45-degree field of view: 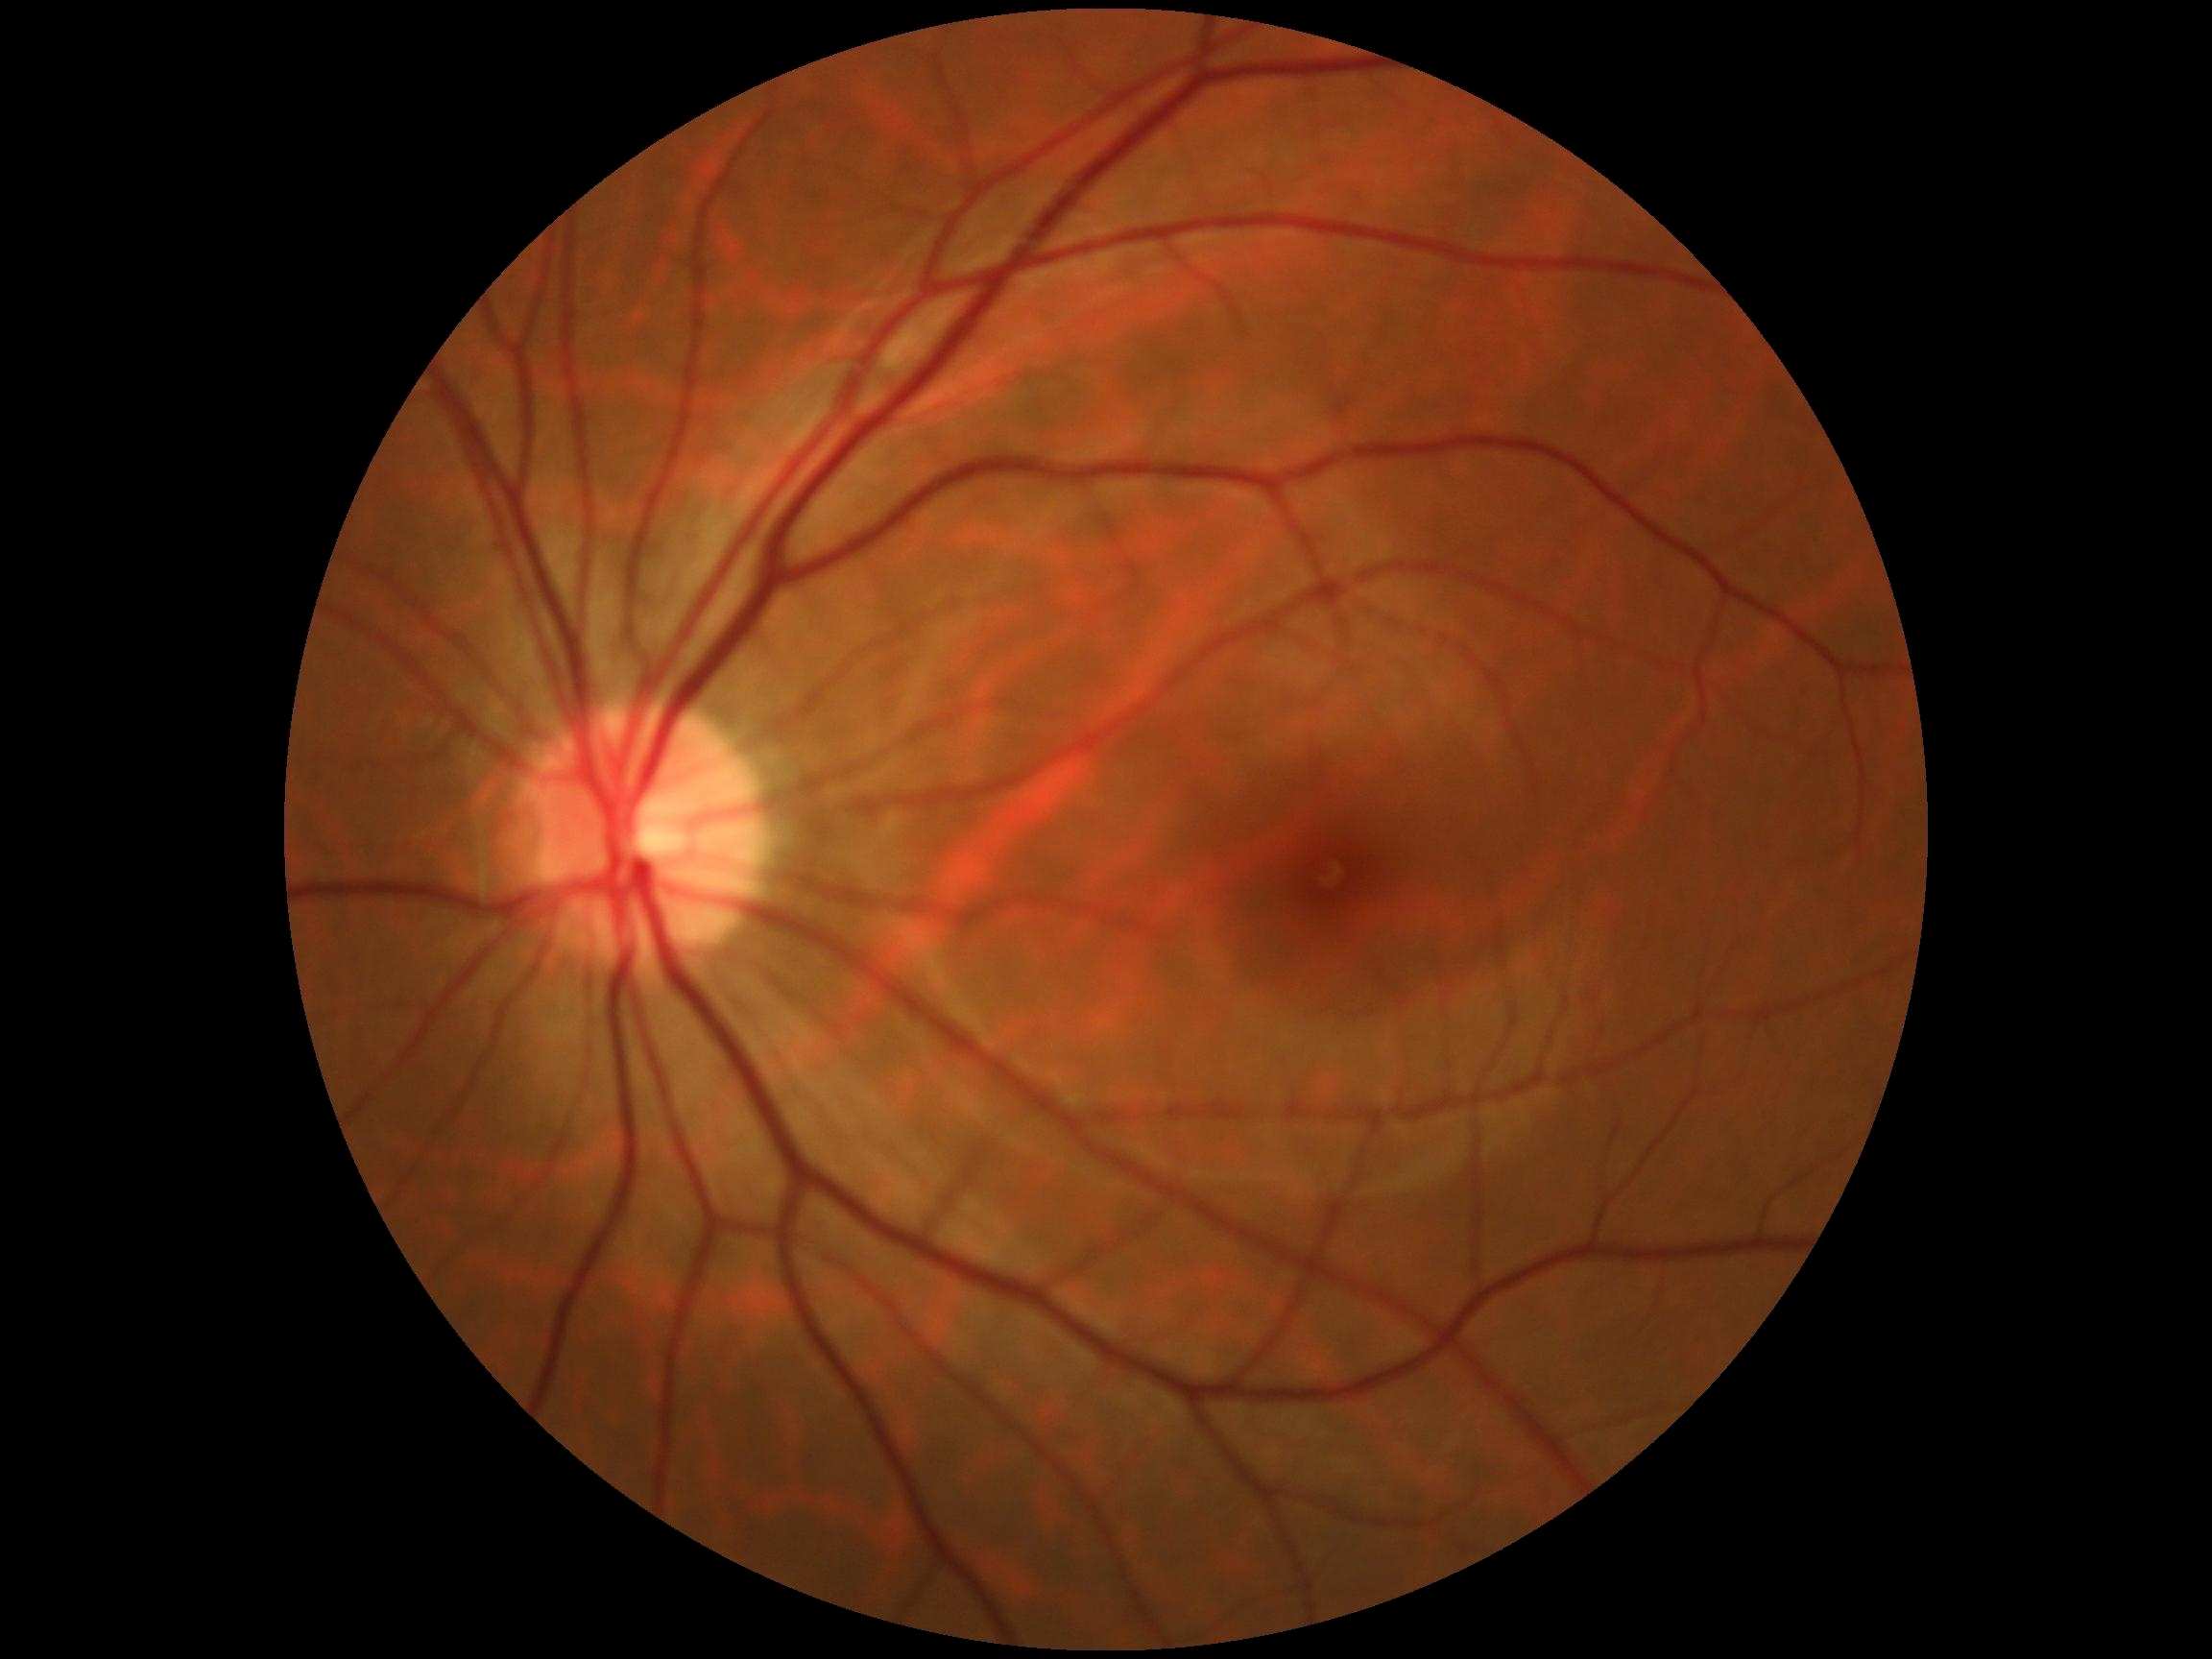 {"dr_grade": "grade 0 (no apparent retinopathy)"}